Modified Davis grading. NIDEK AFC-230 fundus camera: 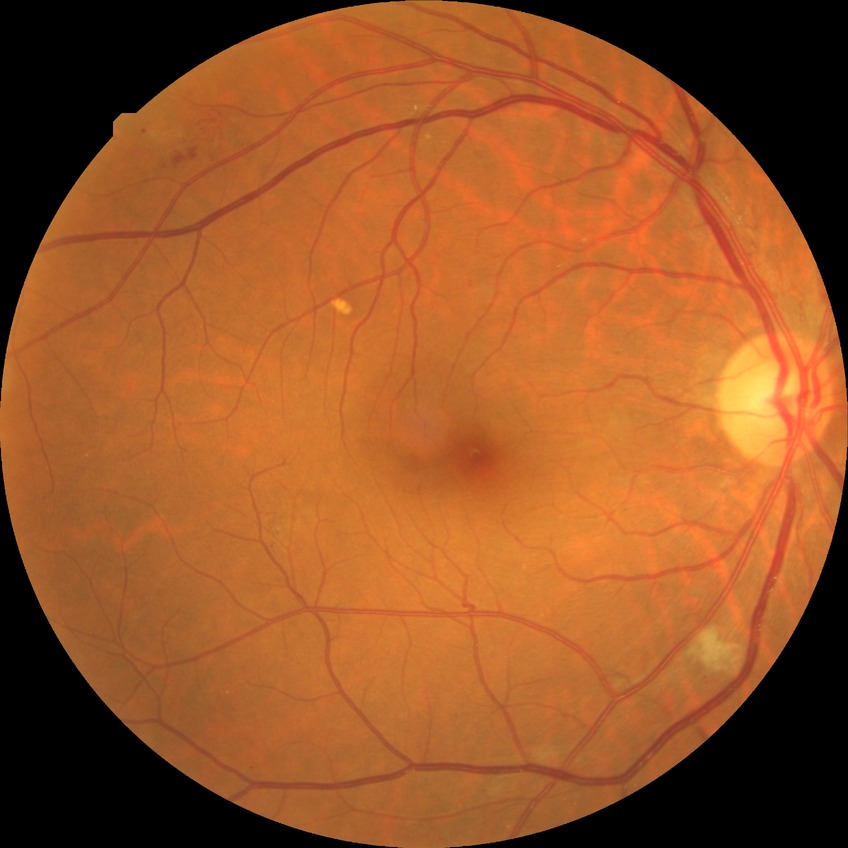
Diabetic retinopathy stage: pre-proliferative diabetic retinopathy. The retinopathy is classified as non-proliferative diabetic retinopathy.